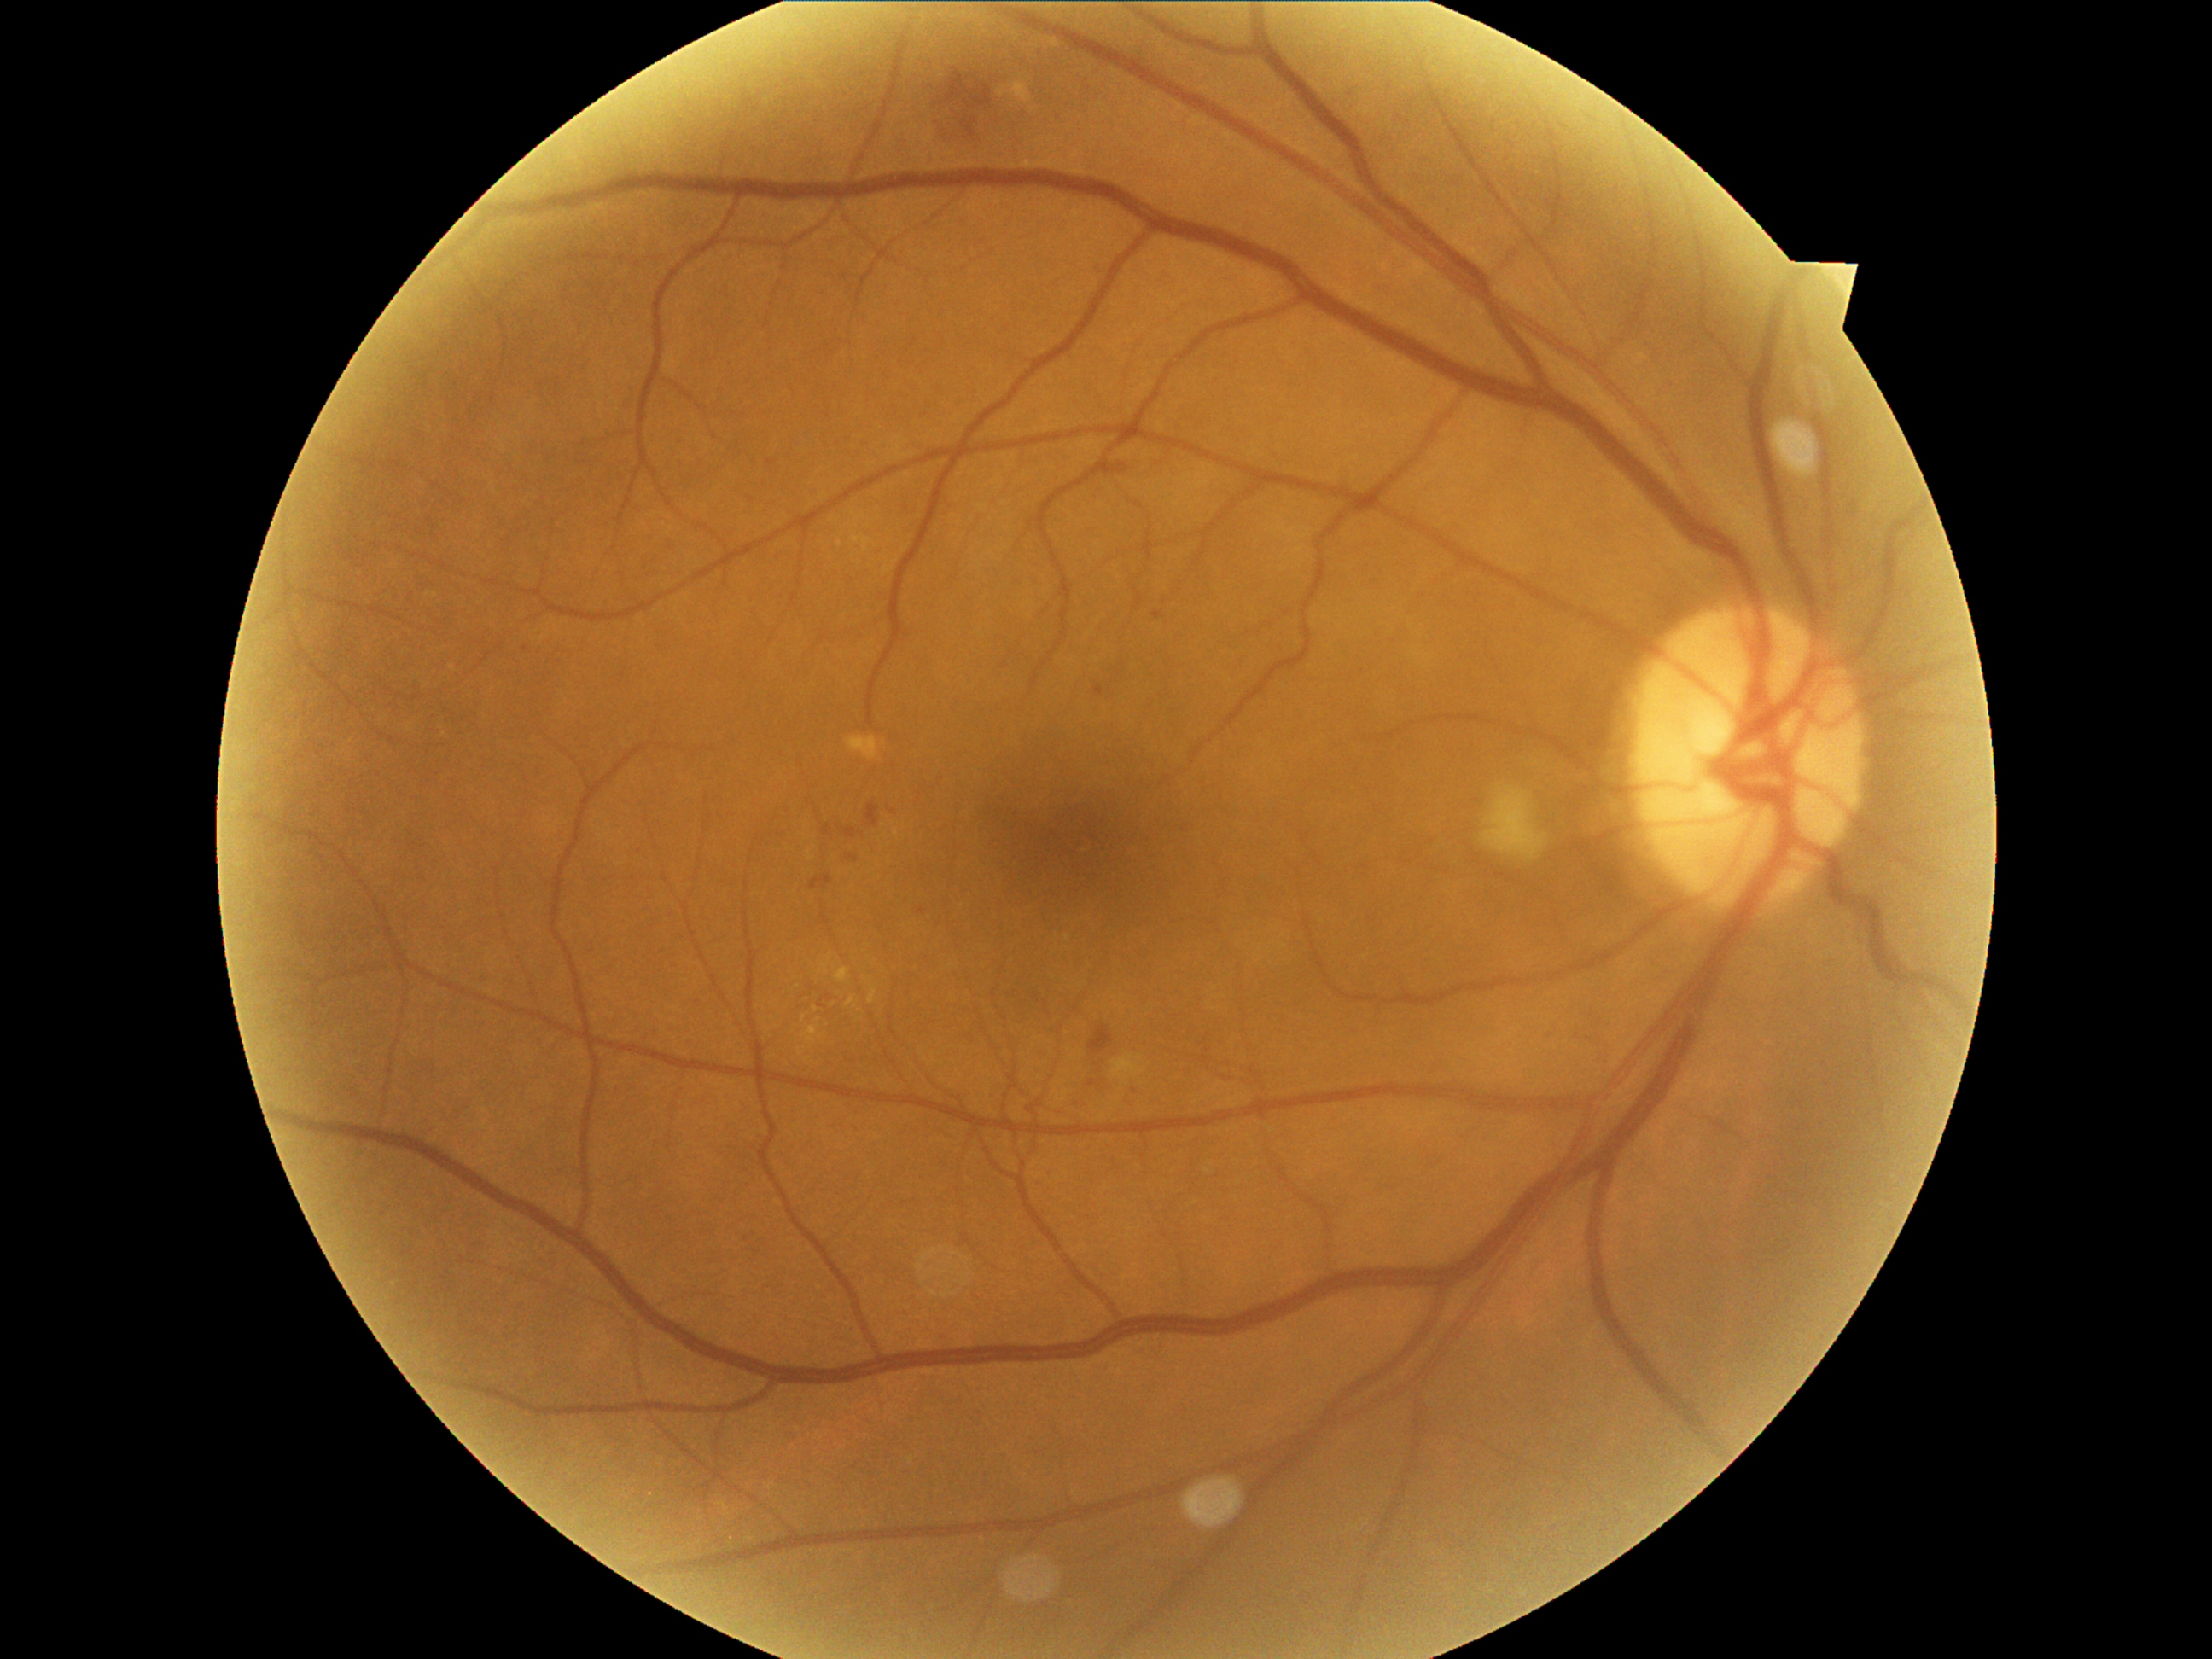

DR grade: 2
A subset of detected lesions:
MAs (subset) = [left=847, top=856, right=859, bottom=863]; [left=846, top=827, right=858, bottom=839]; [left=818, top=1003, right=825, bottom=1011]; [left=1095, top=685, right=1103, bottom=697]; [left=812, top=875, right=832, bottom=890]; [left=1153, top=610, right=1161, bottom=619]
MAs (small, approximate centers) near [x=526, y=648]; [x=921, y=911]; [x=1091, y=1083]
SEs = [left=1112, top=1054, right=1144, bottom=1083]; [left=1487, top=788, right=1544, bottom=864]
EXs (subset) = [left=803, top=1025, right=820, bottom=1044]; [left=870, top=989, right=878, bottom=1004]; [left=834, top=967, right=849, bottom=982]; [left=846, top=996, right=856, bottom=1008]; [left=820, top=965, right=829, bottom=975]
EXs (small, approximate centers) near [x=832, y=955]; [x=868, y=979]; [x=815, y=1009]; [x=804, y=1019]; [x=800, y=1052]; [x=833, y=1005]; [x=798, y=986]; [x=819, y=1021]; [x=859, y=1008]
HEs = [left=967, top=119, right=977, bottom=132]; [left=972, top=84, right=992, bottom=107]; [left=1088, top=1027, right=1115, bottom=1054]; [left=866, top=805, right=880, bottom=829]; [left=948, top=71, right=970, bottom=102]
HEs (small, approximate centers) near [x=972, y=108]